CFP: 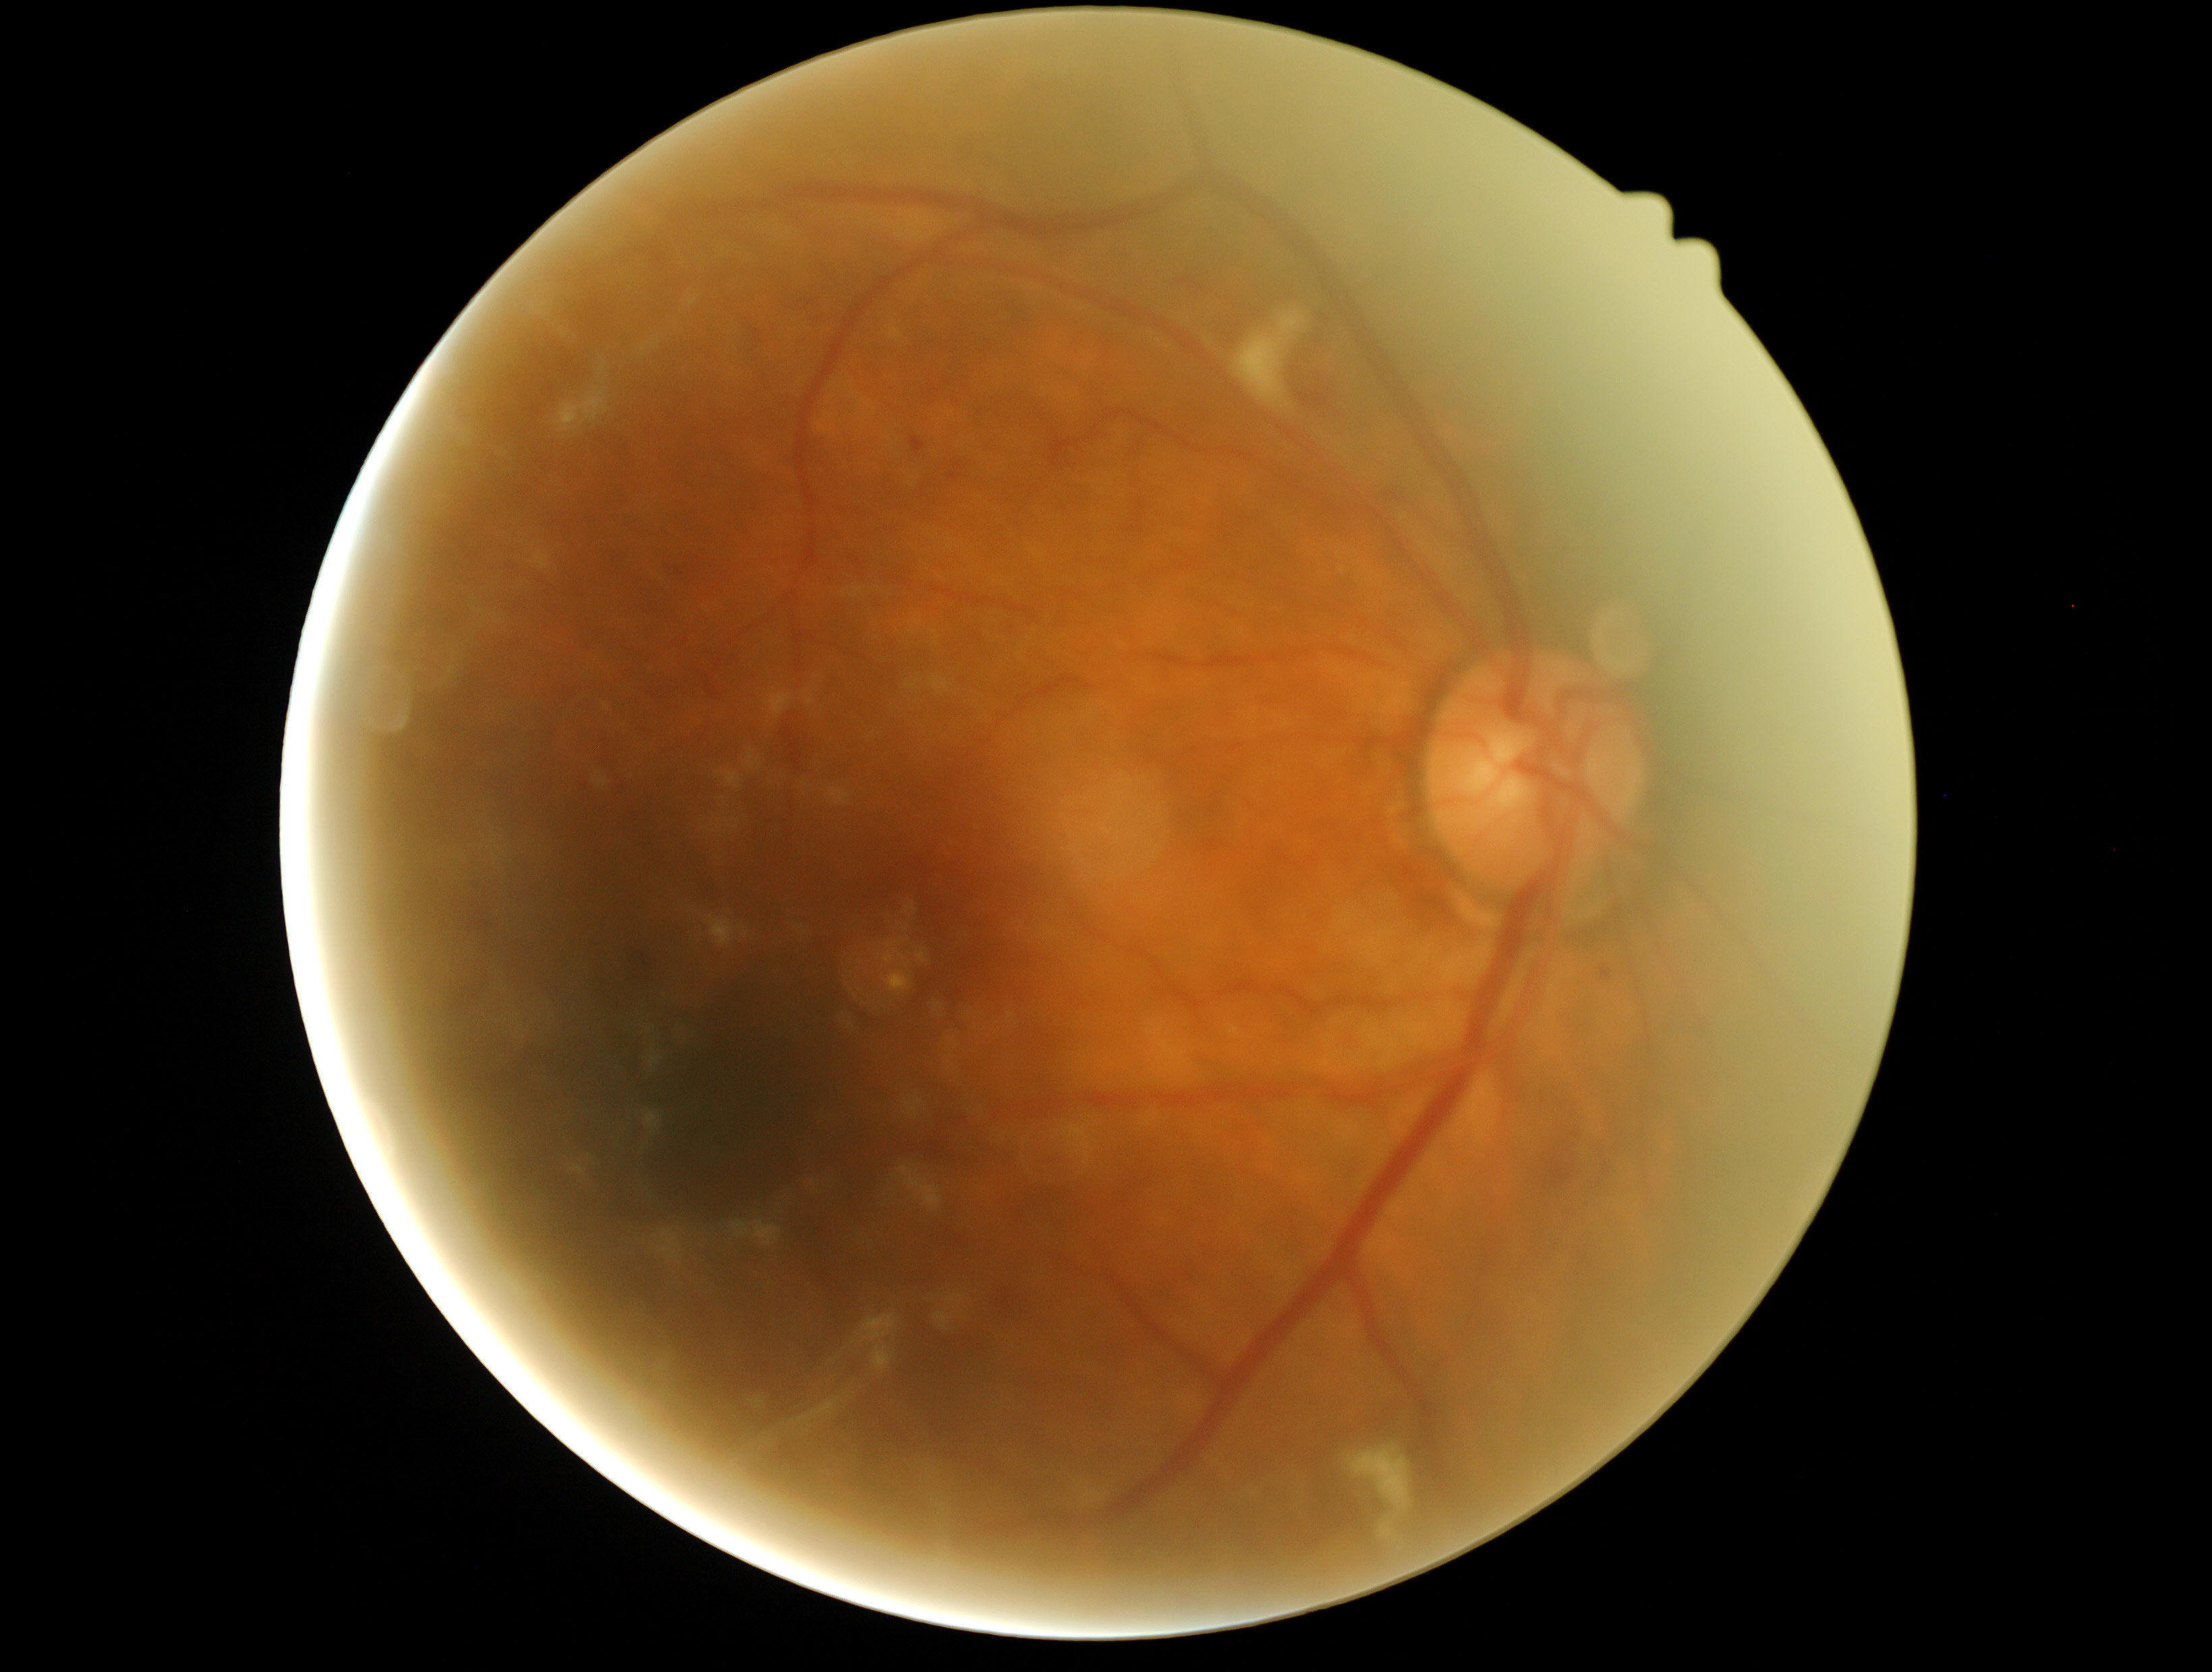
DR severity is moderate NPDR (grade 2) — more than just microaneurysms but less than severe NPDR.